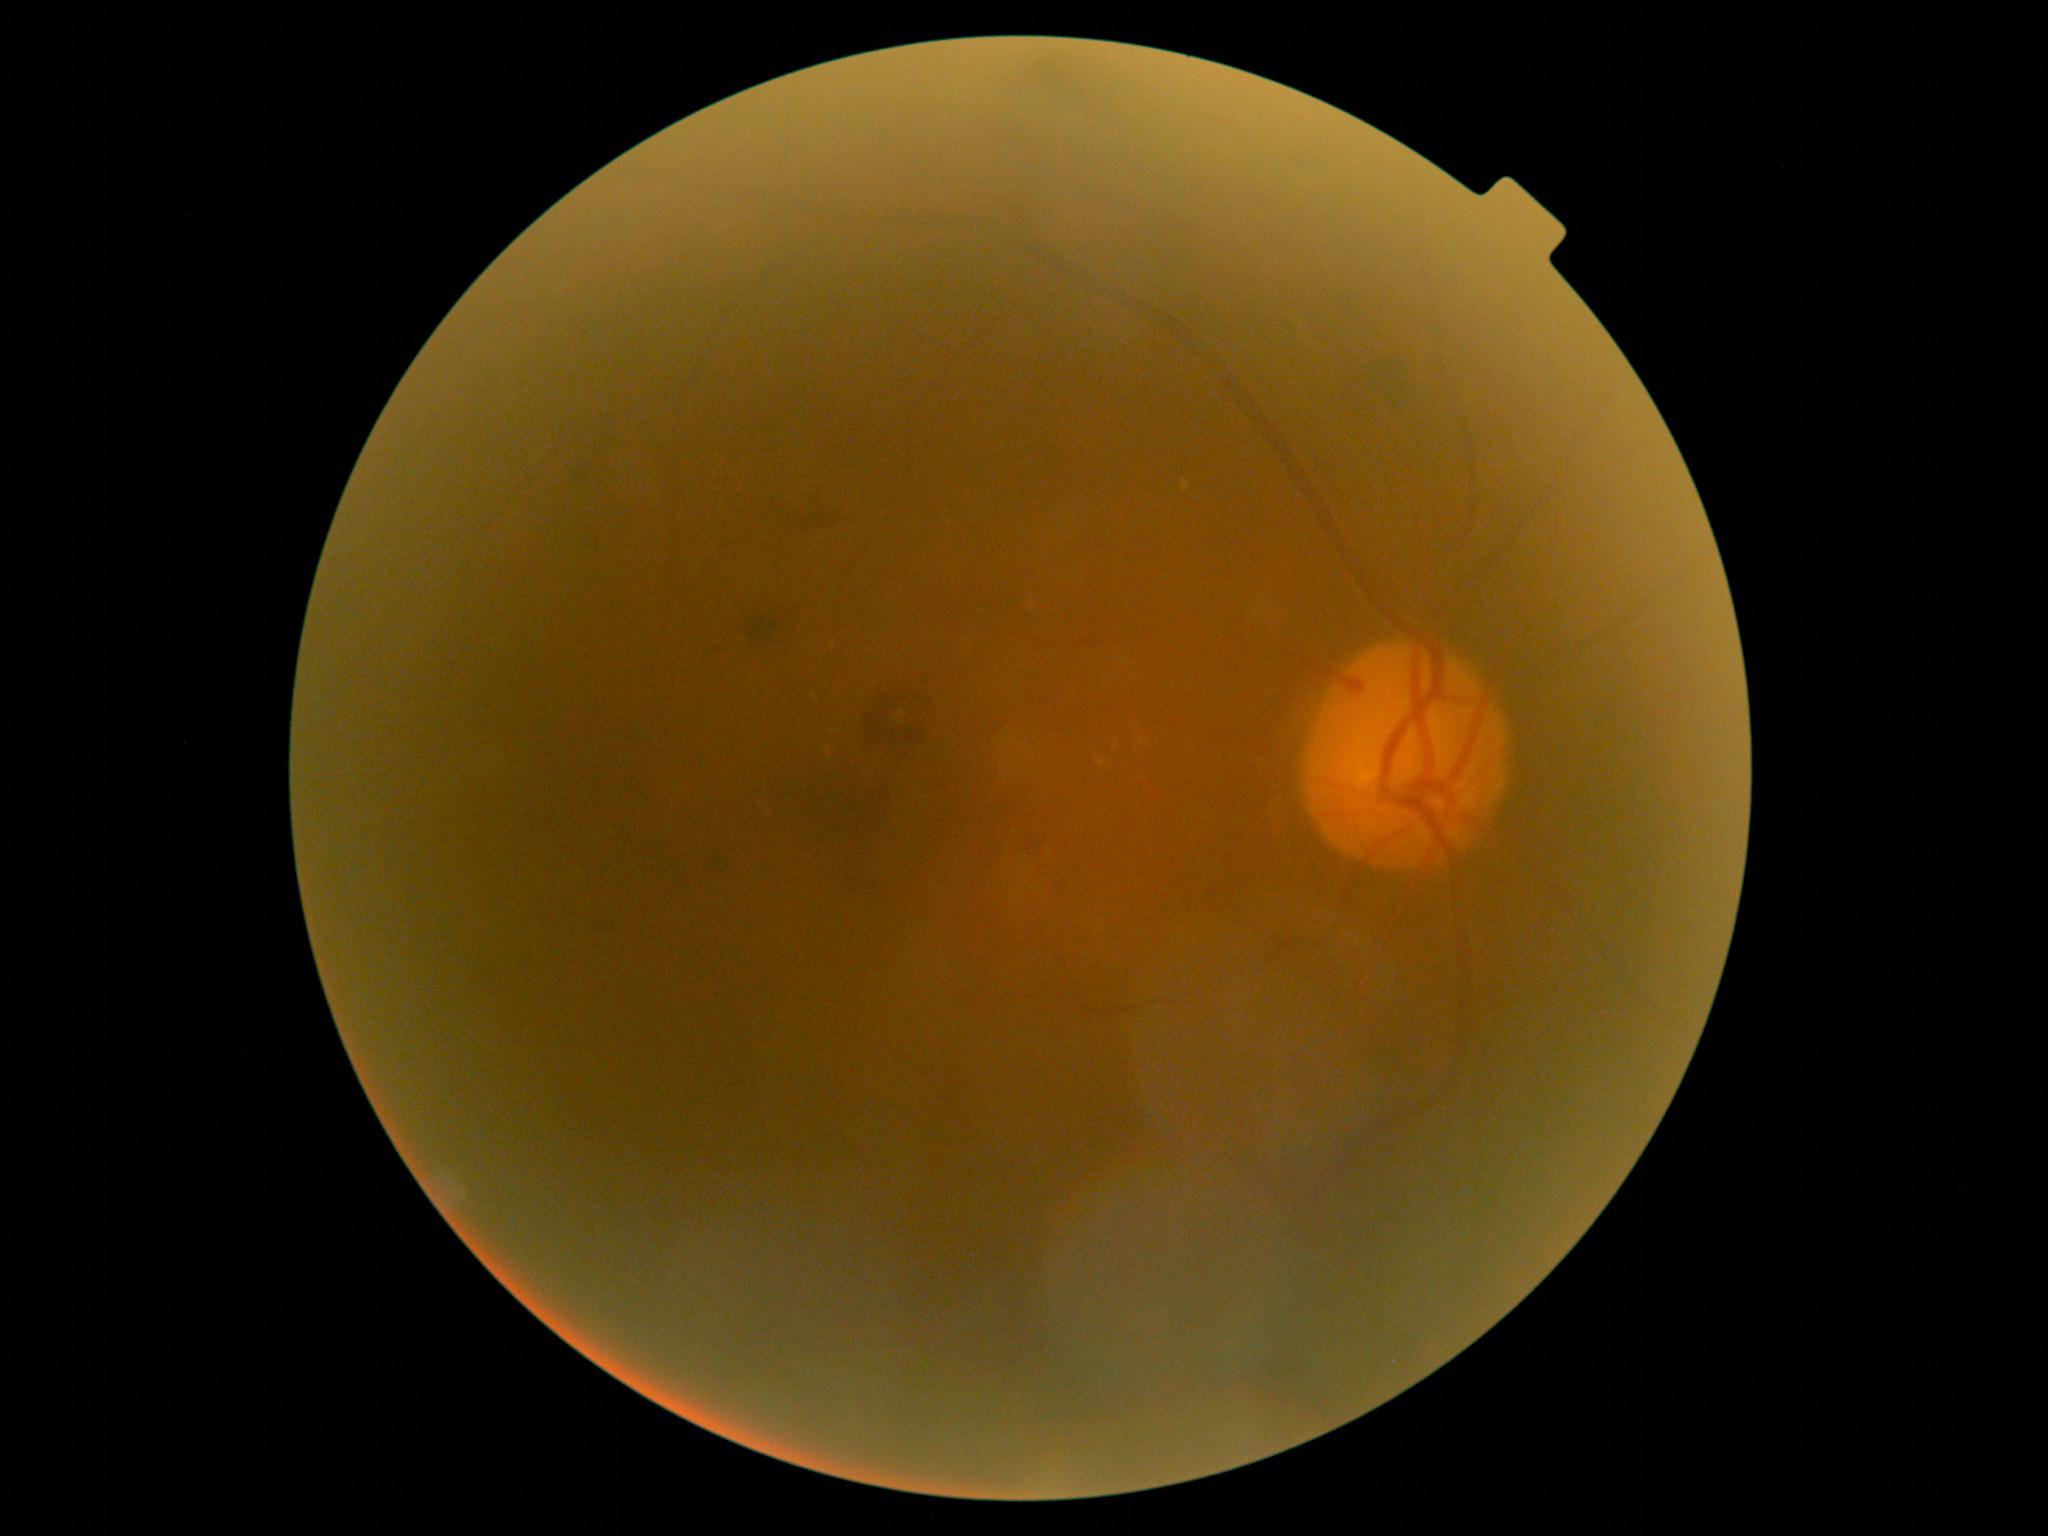

diabetic retinopathy severity = 2.